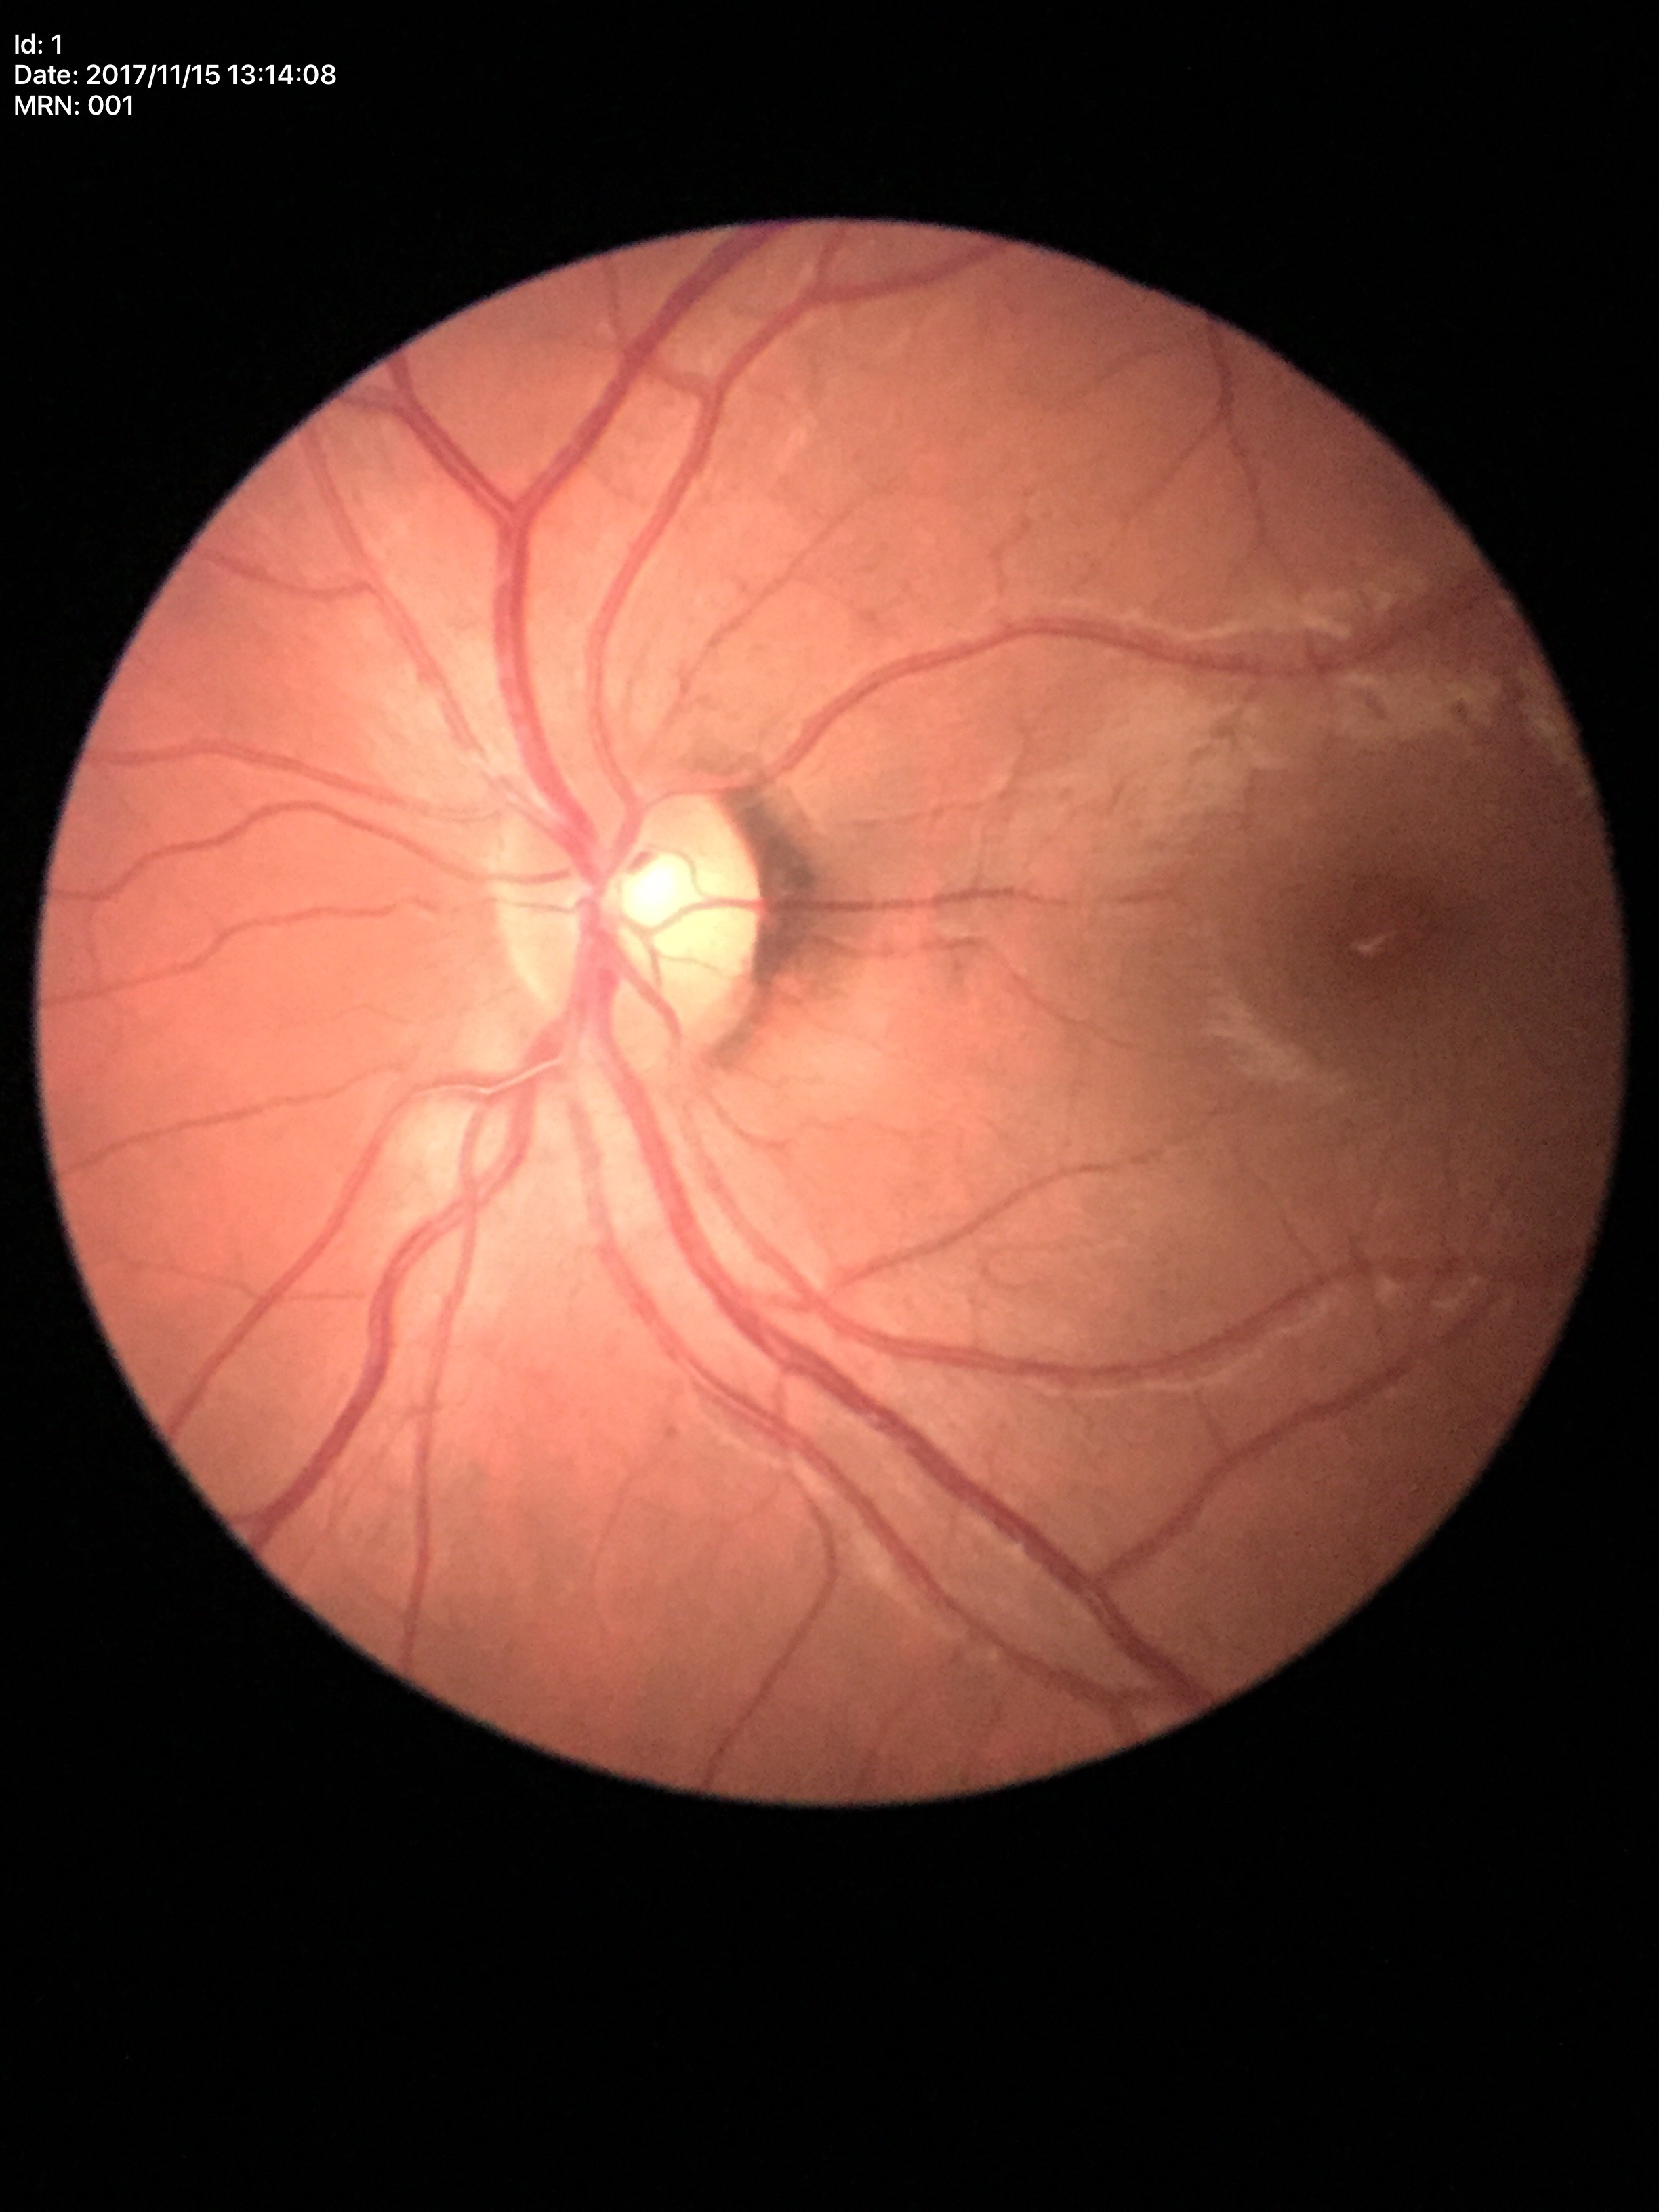

Negative for glaucoma suspicion (1/5 graders called glaucoma suspect). Vertical CDR is 0.51.